Pediatric retinal photograph (wide-field).
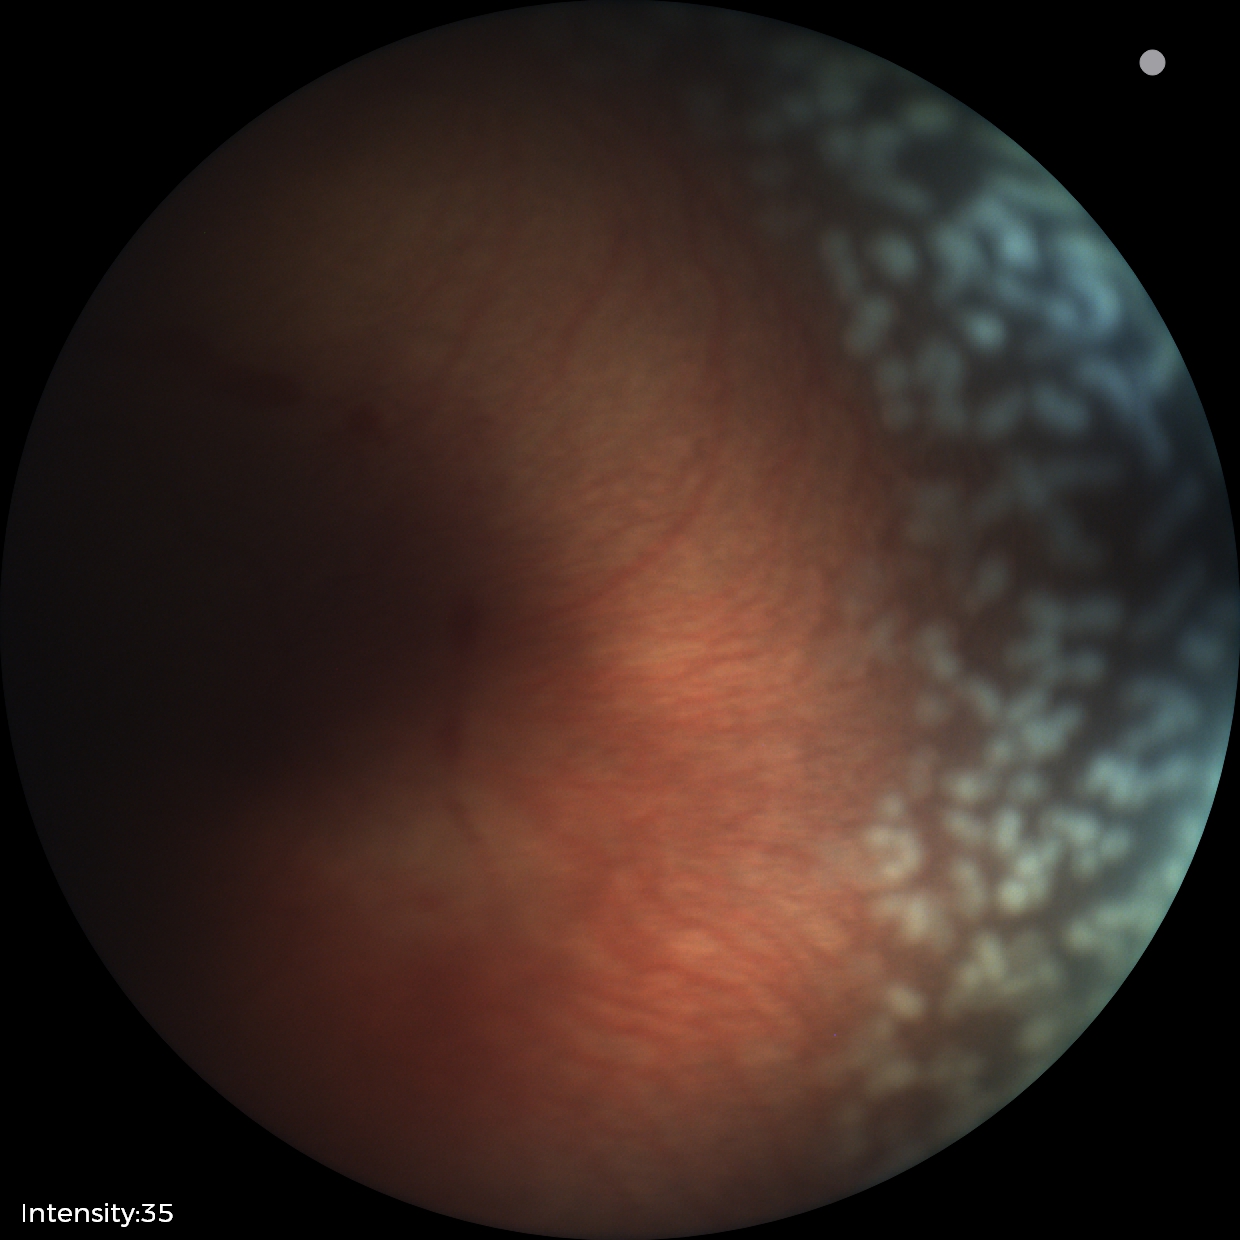
Plus disease was diagnosed.
Screening examination consistent with retinopathy of prematurity (ROP) stage 2 — ridge with height and width at the demarcation line.